Dilated-pupil acquisition: 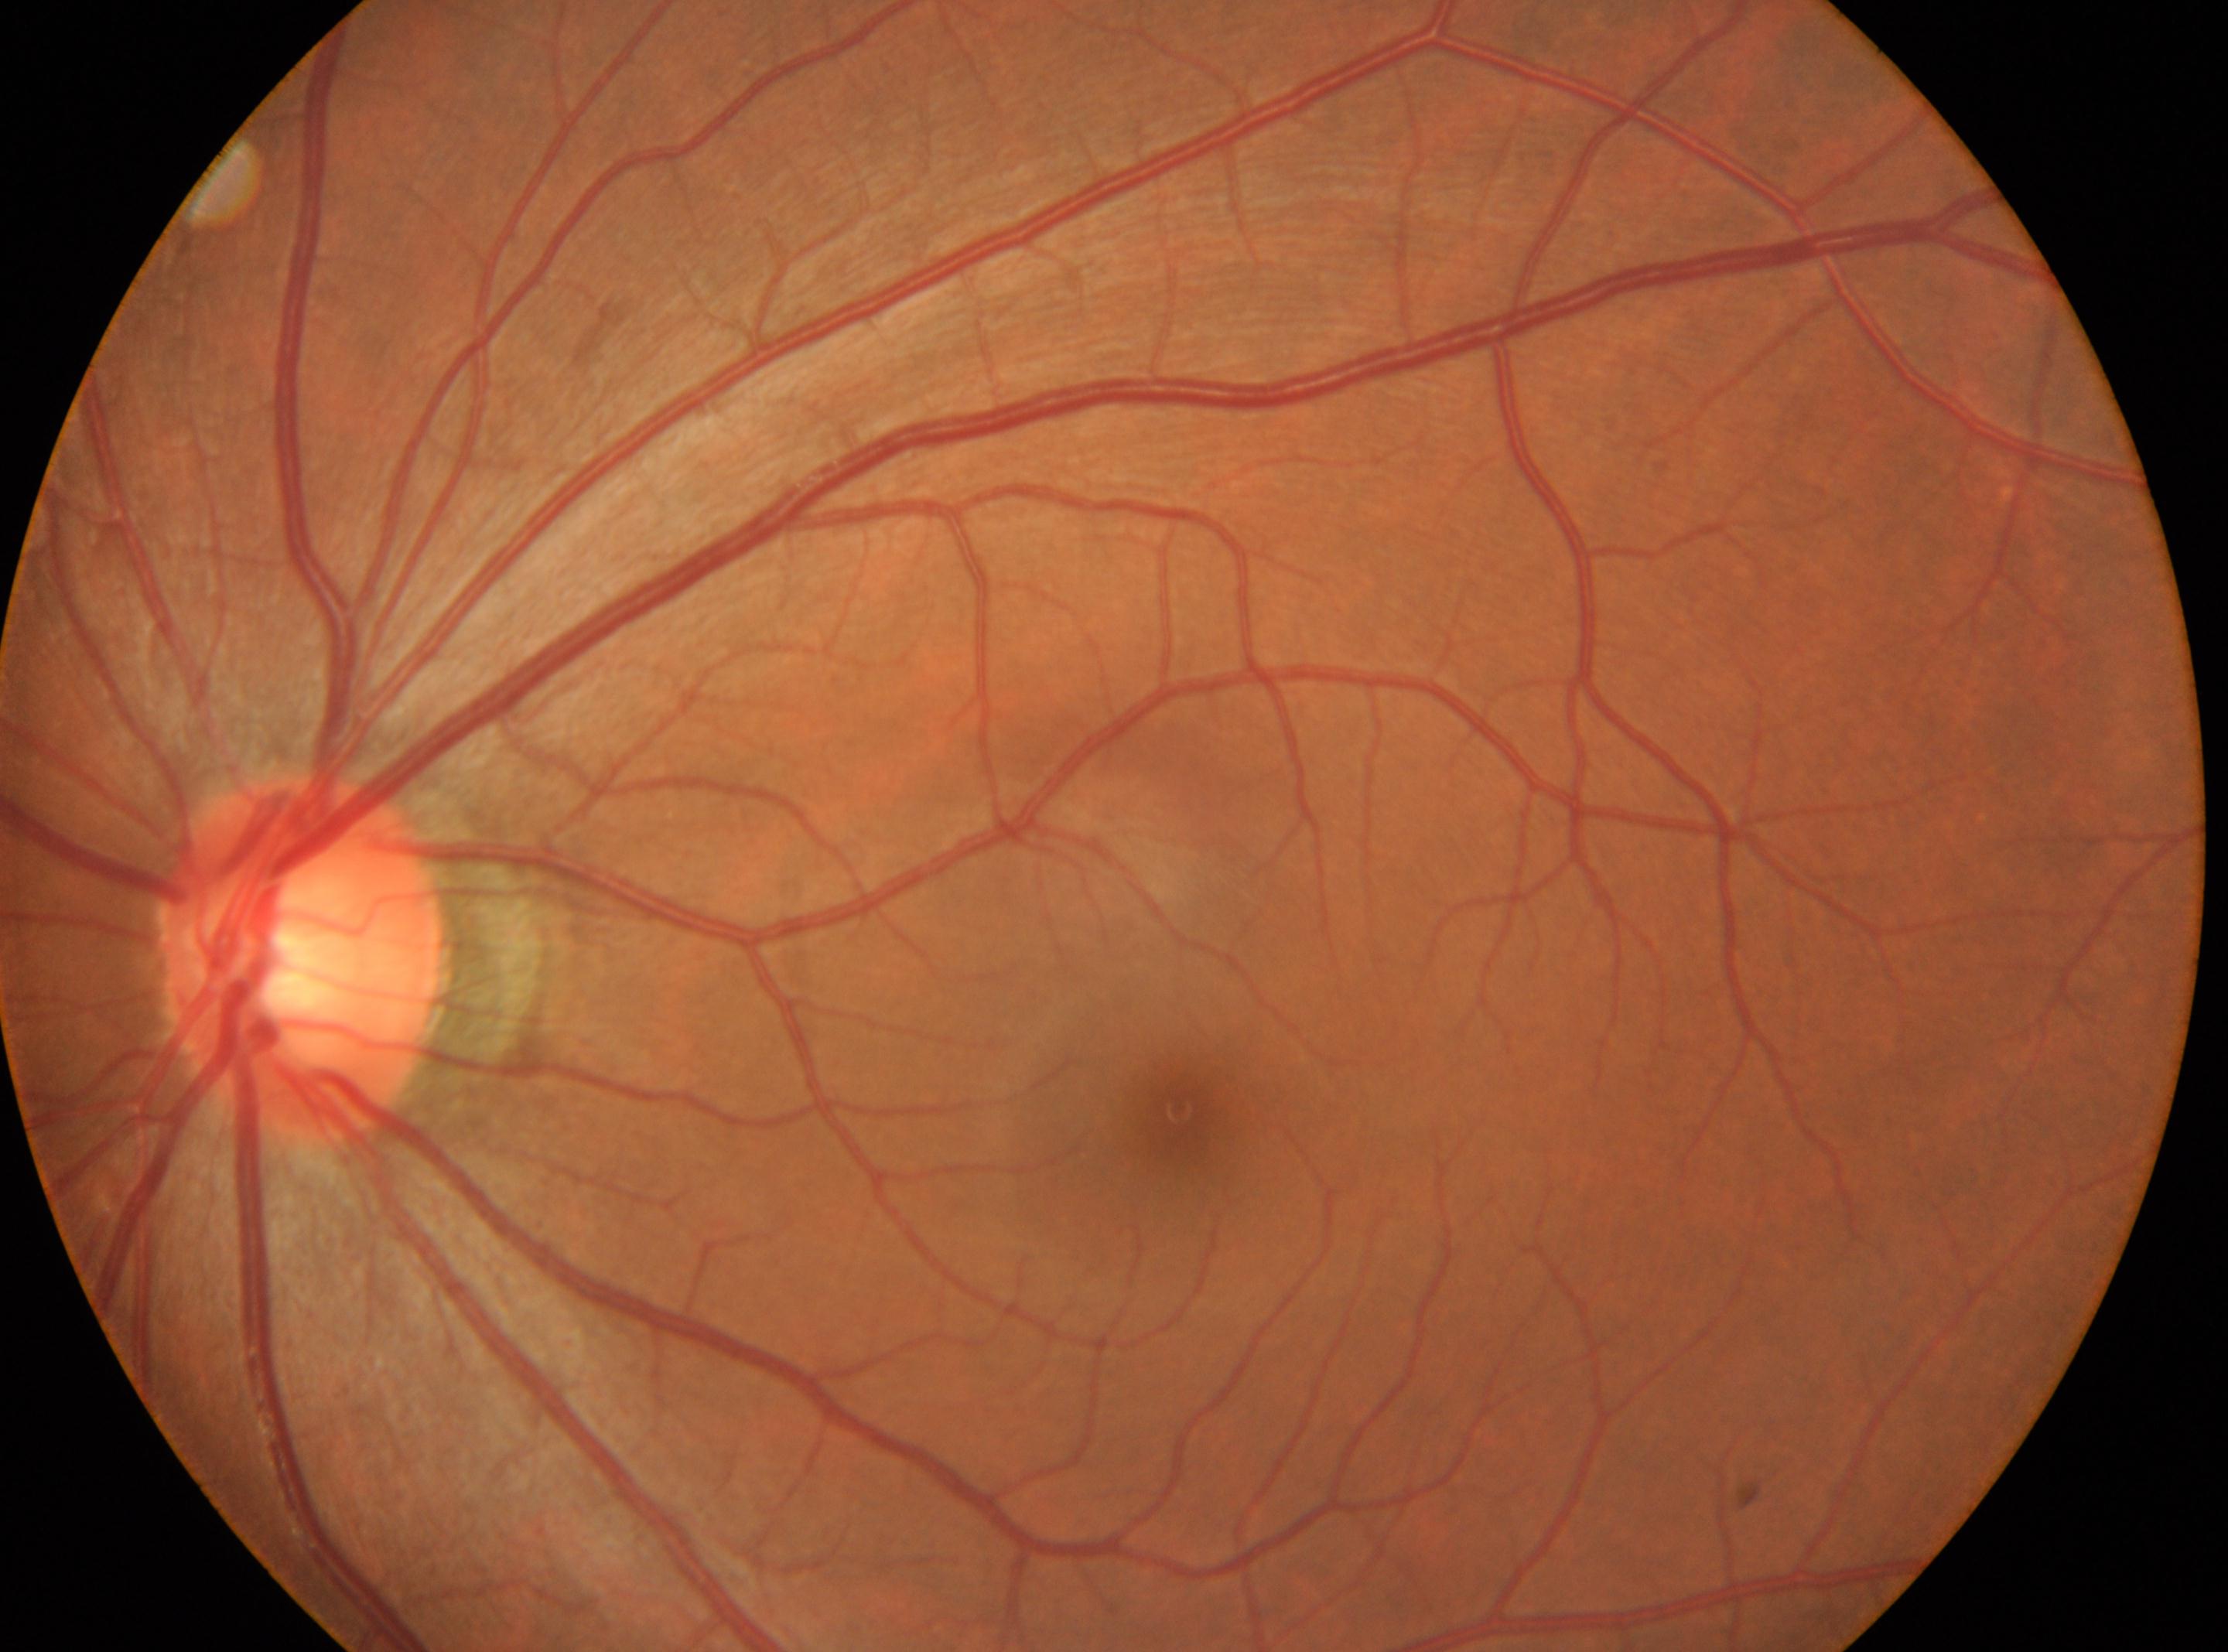

Macular center located at (x=1179, y=1108). The image shows the OS. Retinopathy is grade 0 (no apparent retinopathy). No apparent diabetic retinopathy. The optic disk is at (x=306, y=958).